1659 x 2212 pixels.
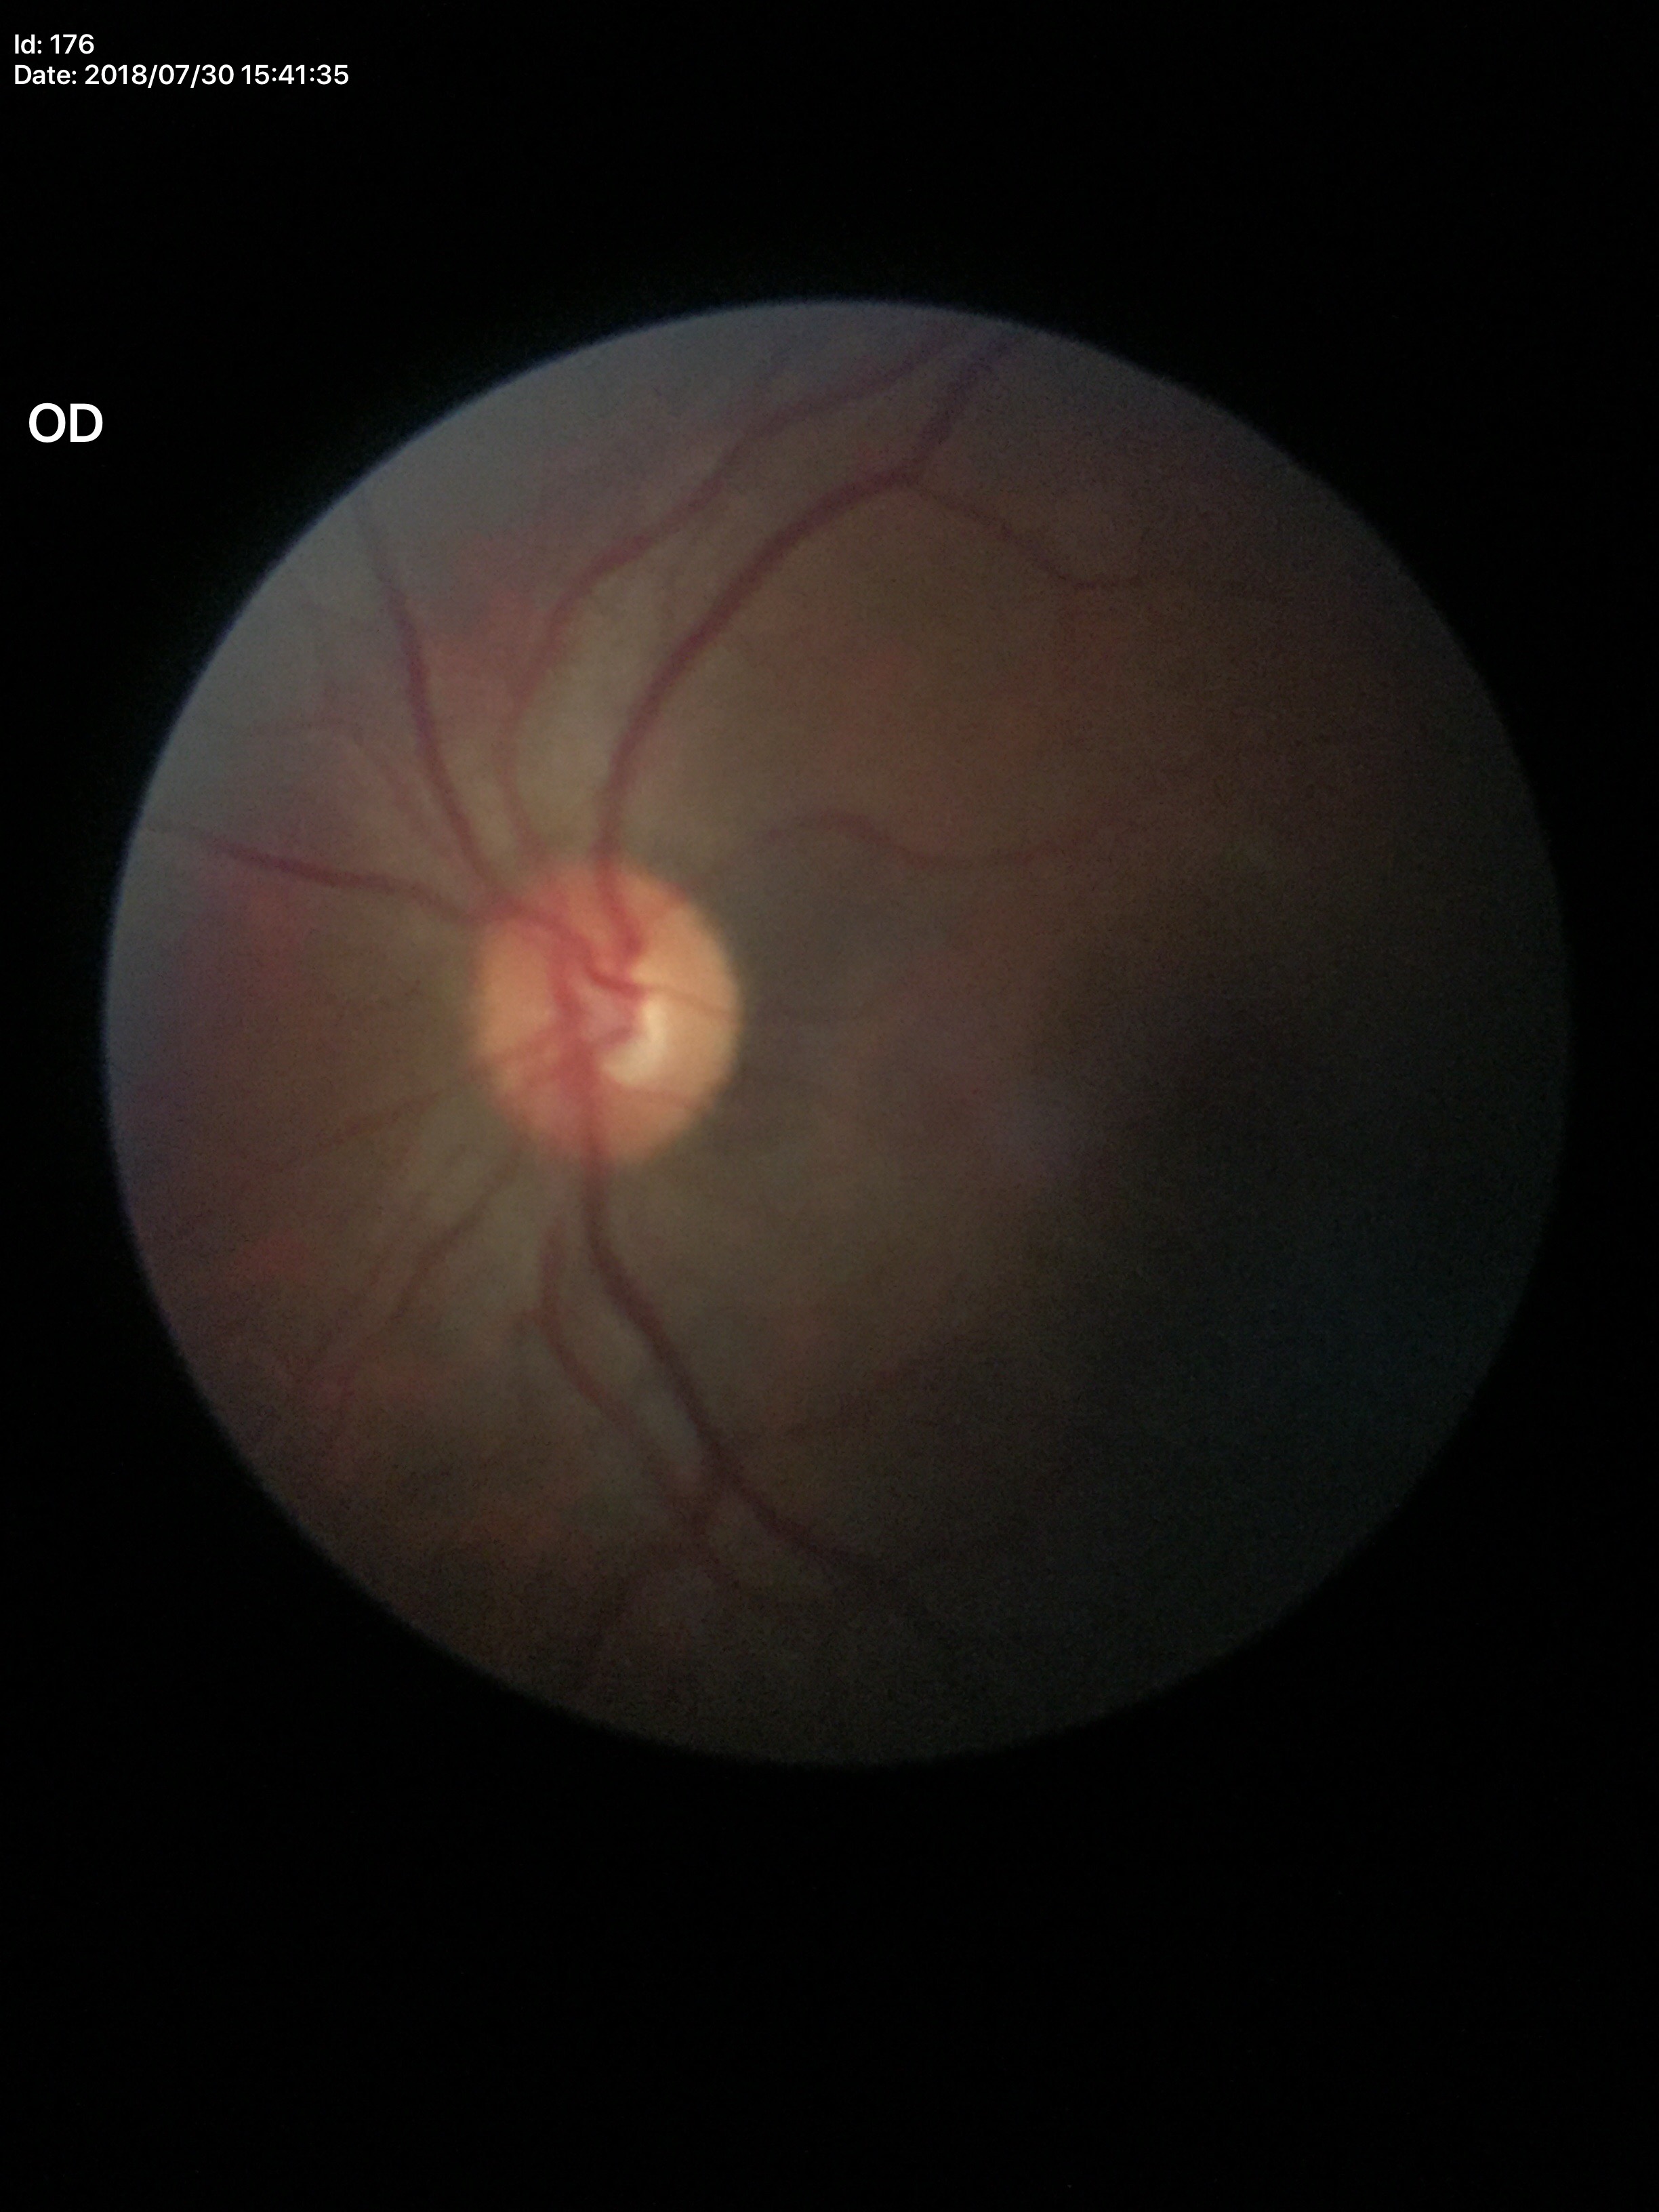

Glaucoma evaluation: no suspicious findings (2/5 graders called glaucoma suspect).
Vertical cup-disc ratio (VCDR) of 0.53.
Horizontal cup-to-disc ratio (HCDR) of 0.50.